Without pupil dilation. Color fundus photograph. Davis DR grading:
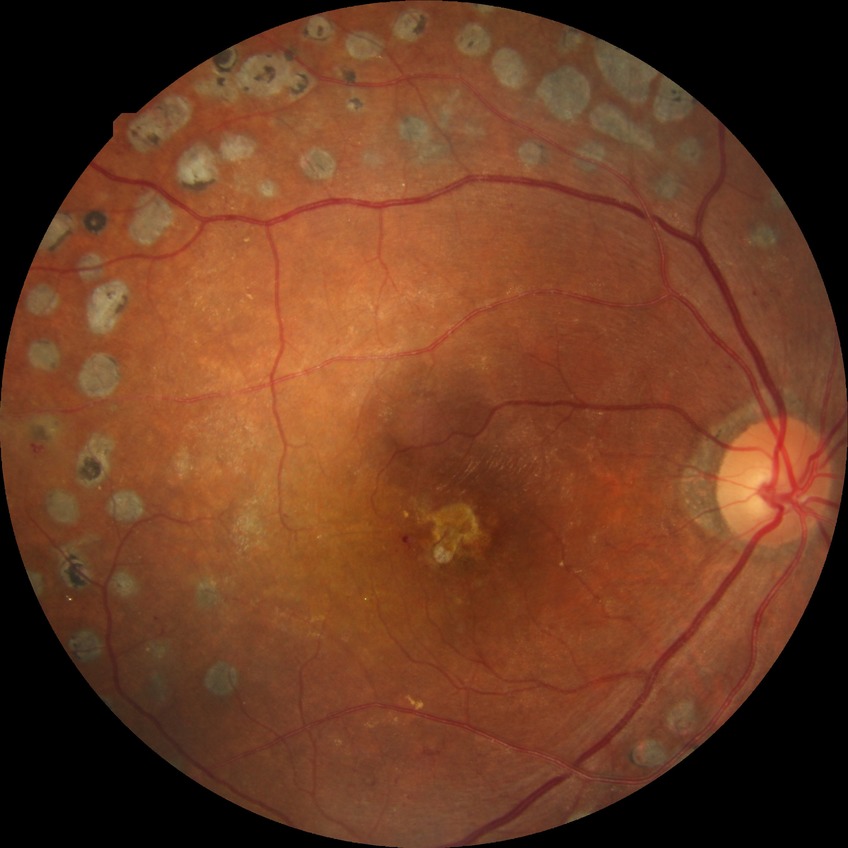
{
  "davis_grade": "proliferative diabetic retinopathy (PDR)"
}